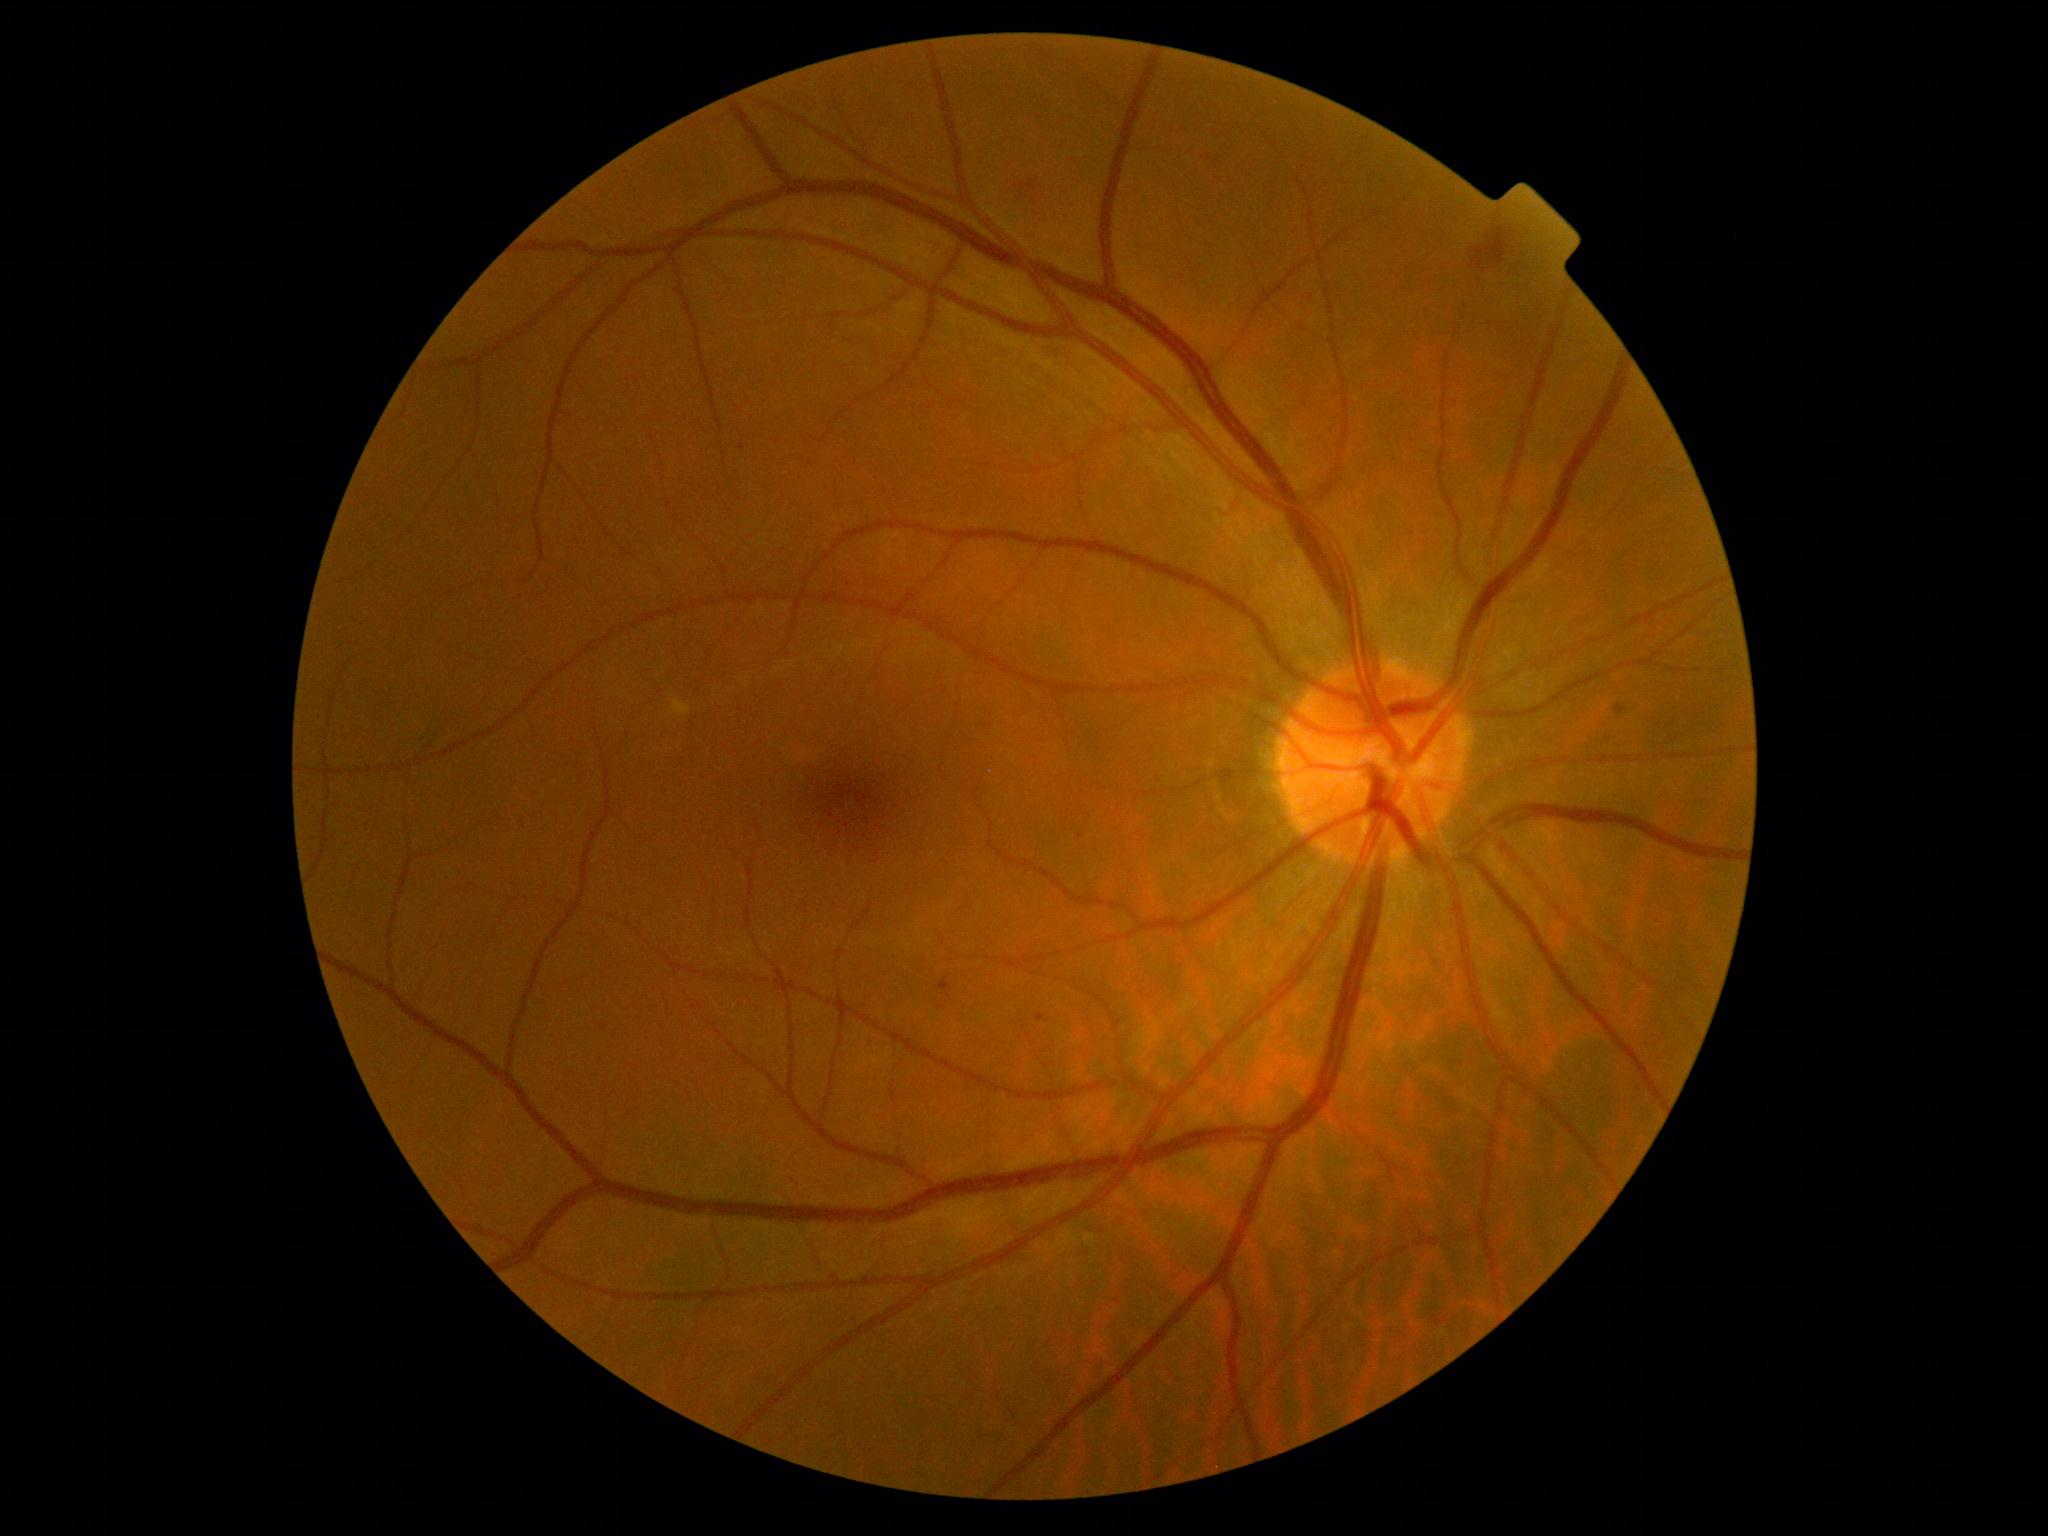

diabetic retinopathy (DR) = grade 2